Pediatric wide-field fundus photograph · 1440 by 1080 pixels
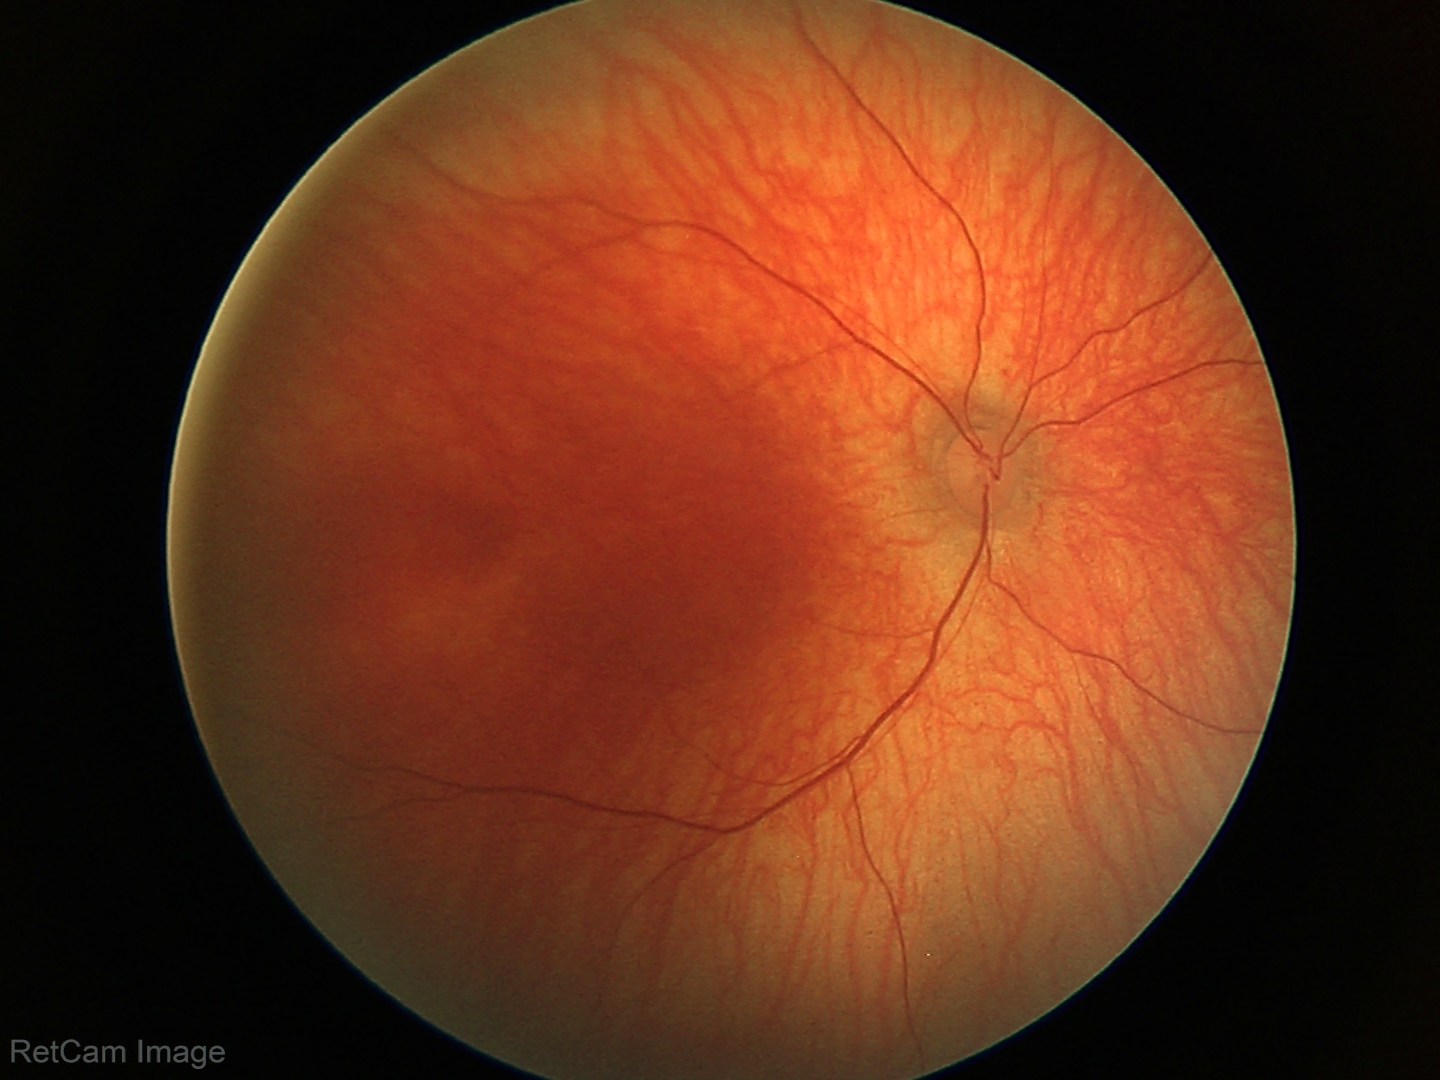

Physiological retinal appearance for postconceptual age.